Acquired with a NIDEK AFC-230; Davis DR grading; without pupil dilation: 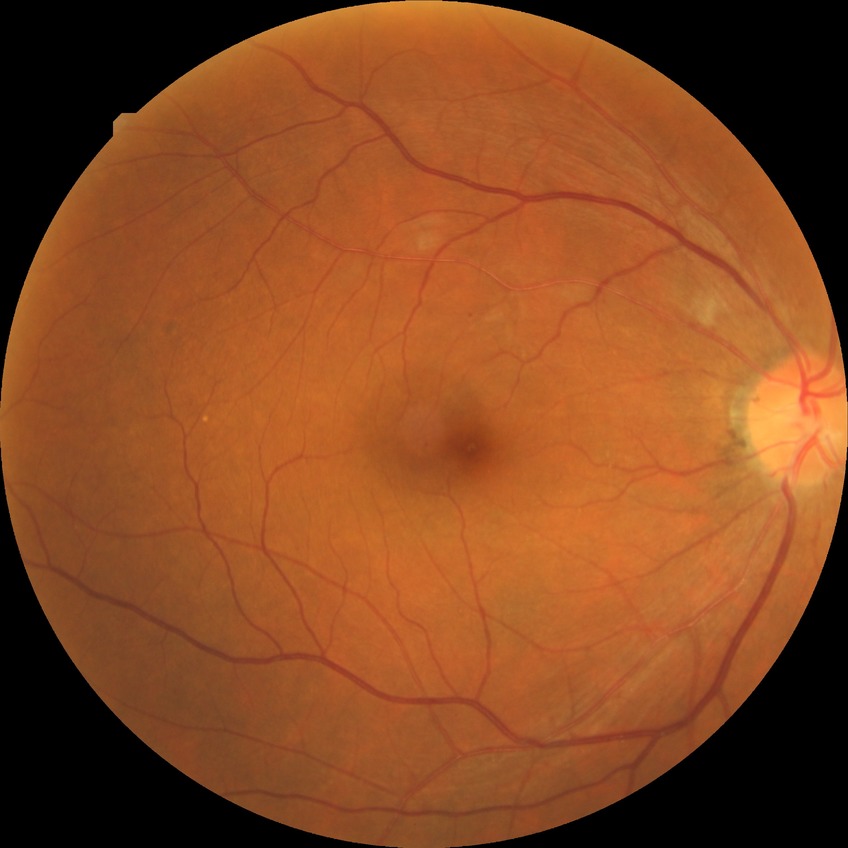 diabetic retinopathy (DR)@NDR (no diabetic retinopathy).